Color fundus photograph.
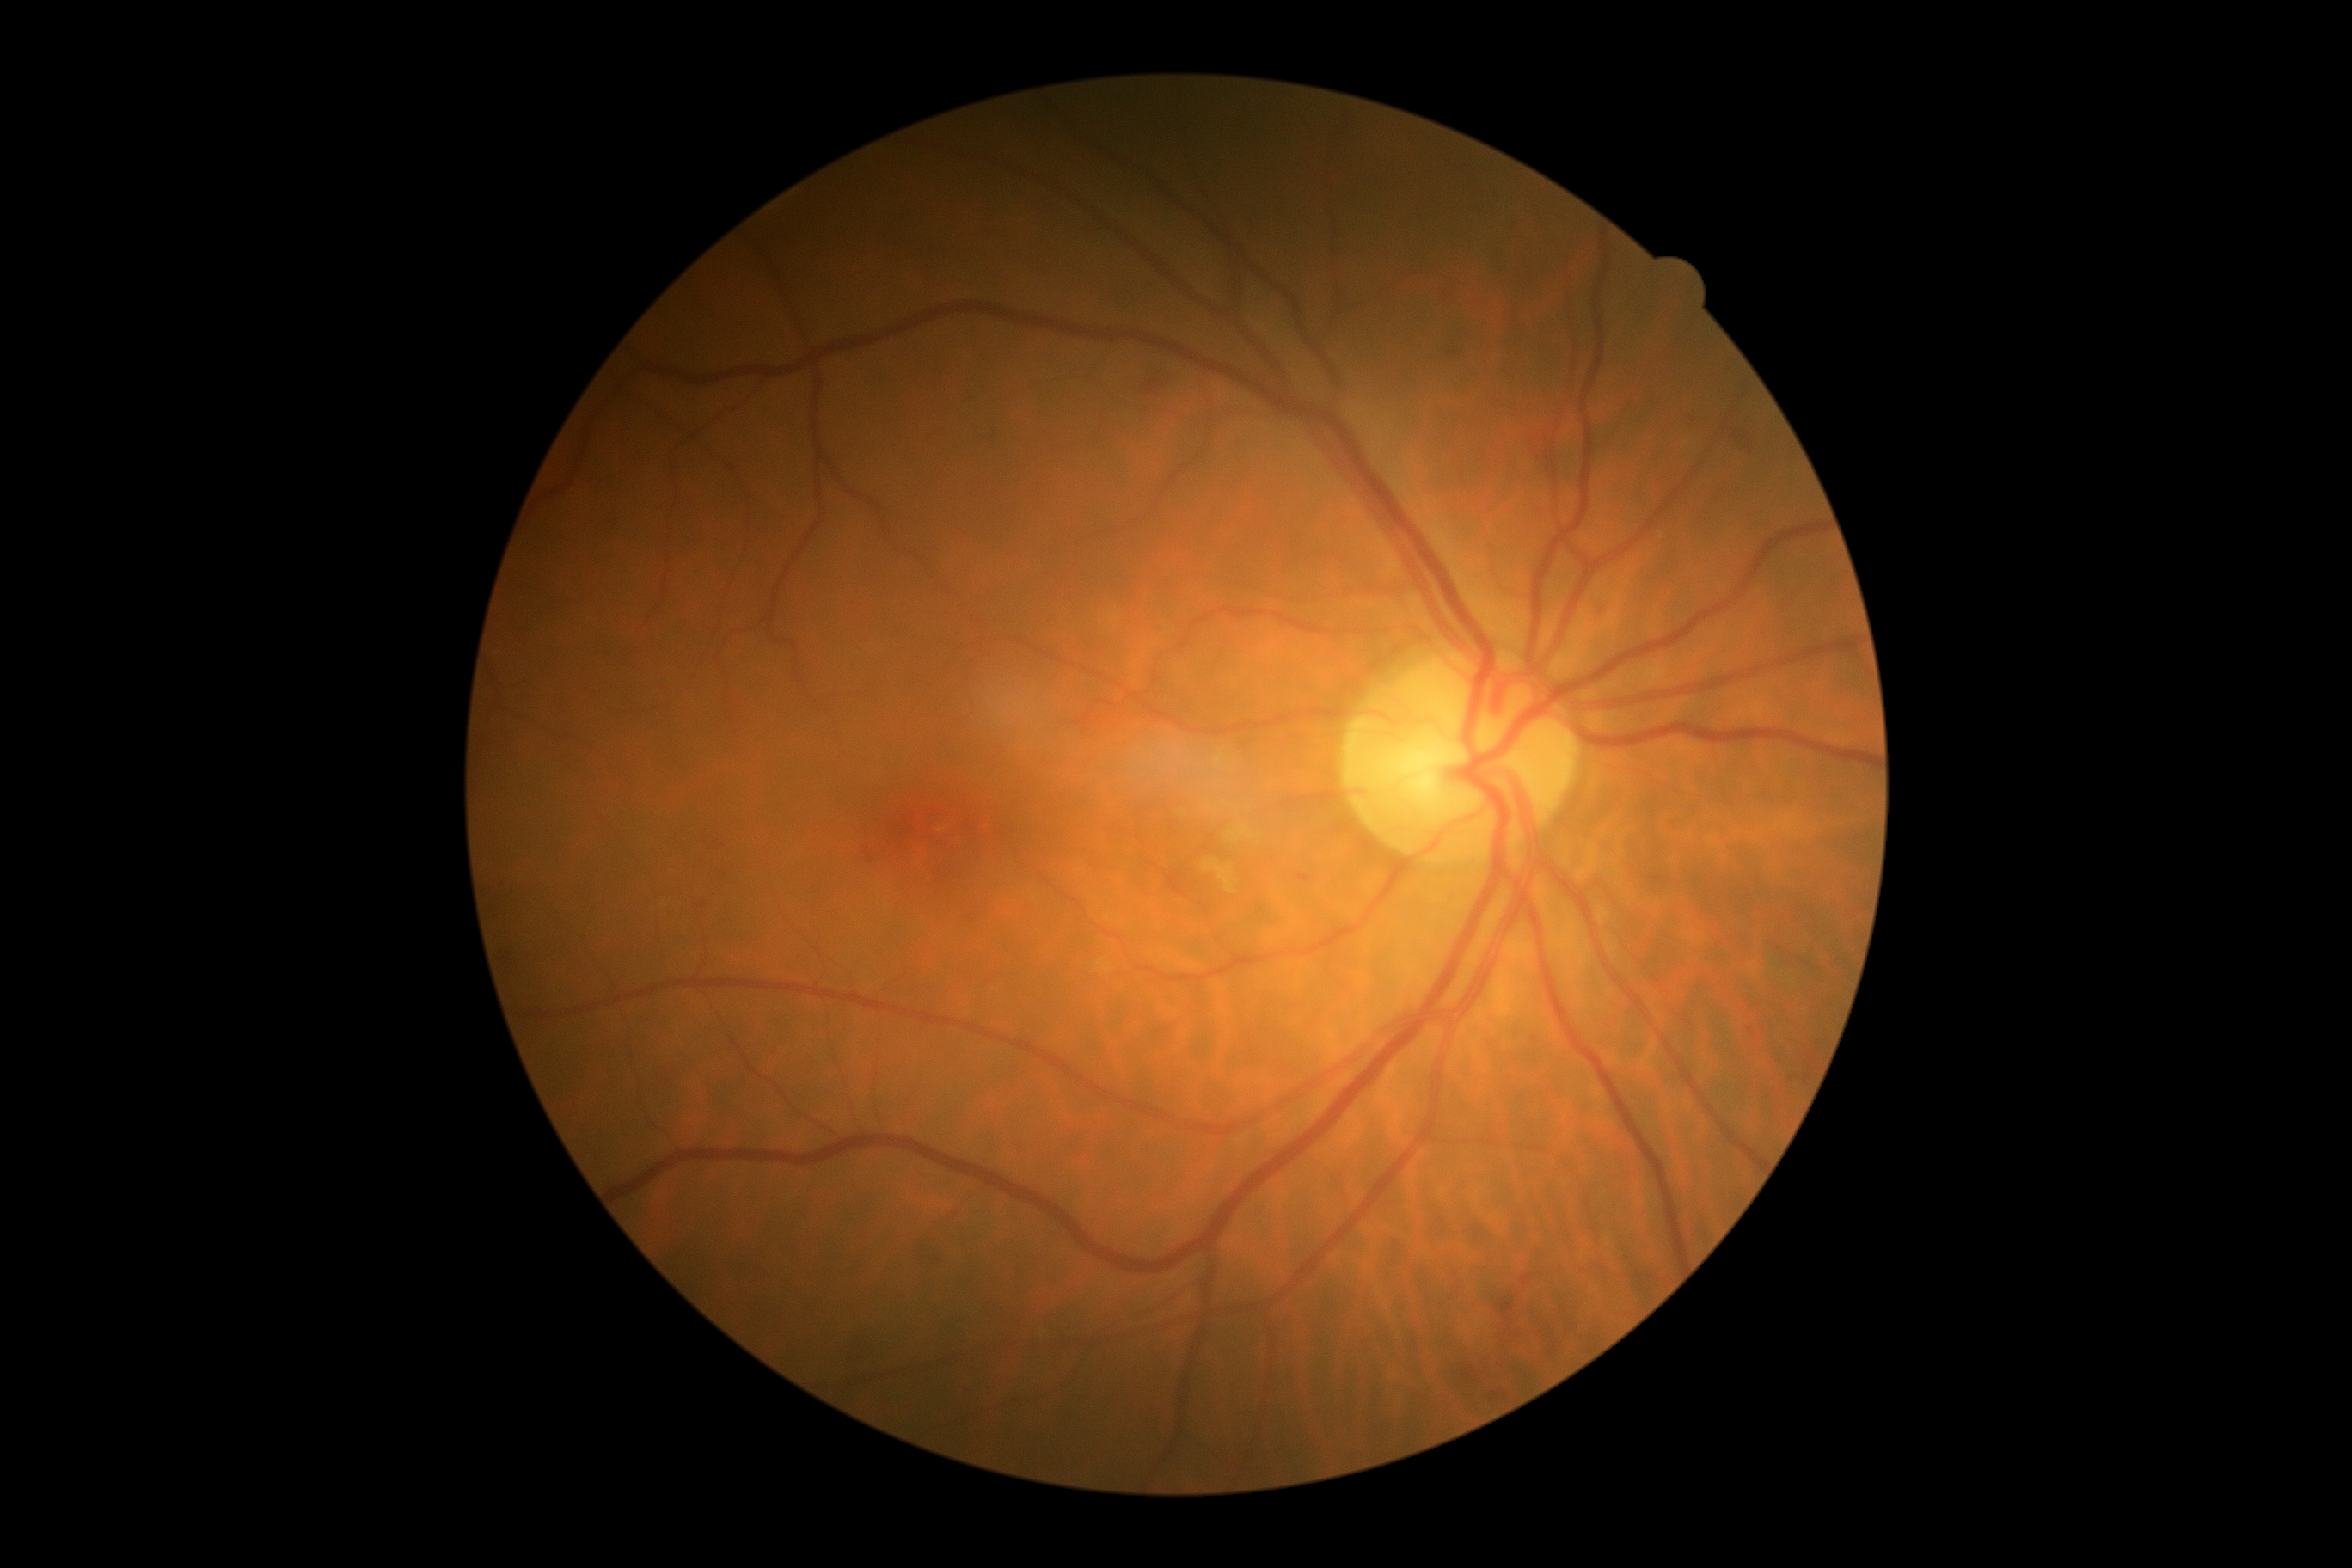

diabetic retinopathy: 2.